Without pupil dilation — 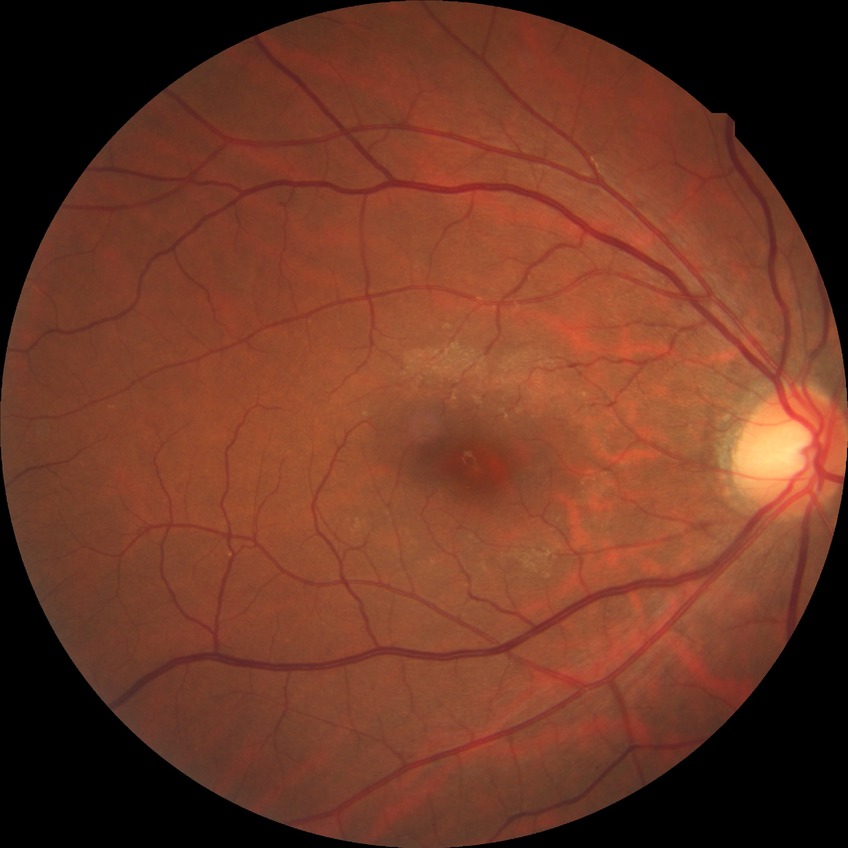 Modified Davis grade: NDR.